50-degree field of view, 2228x1652:
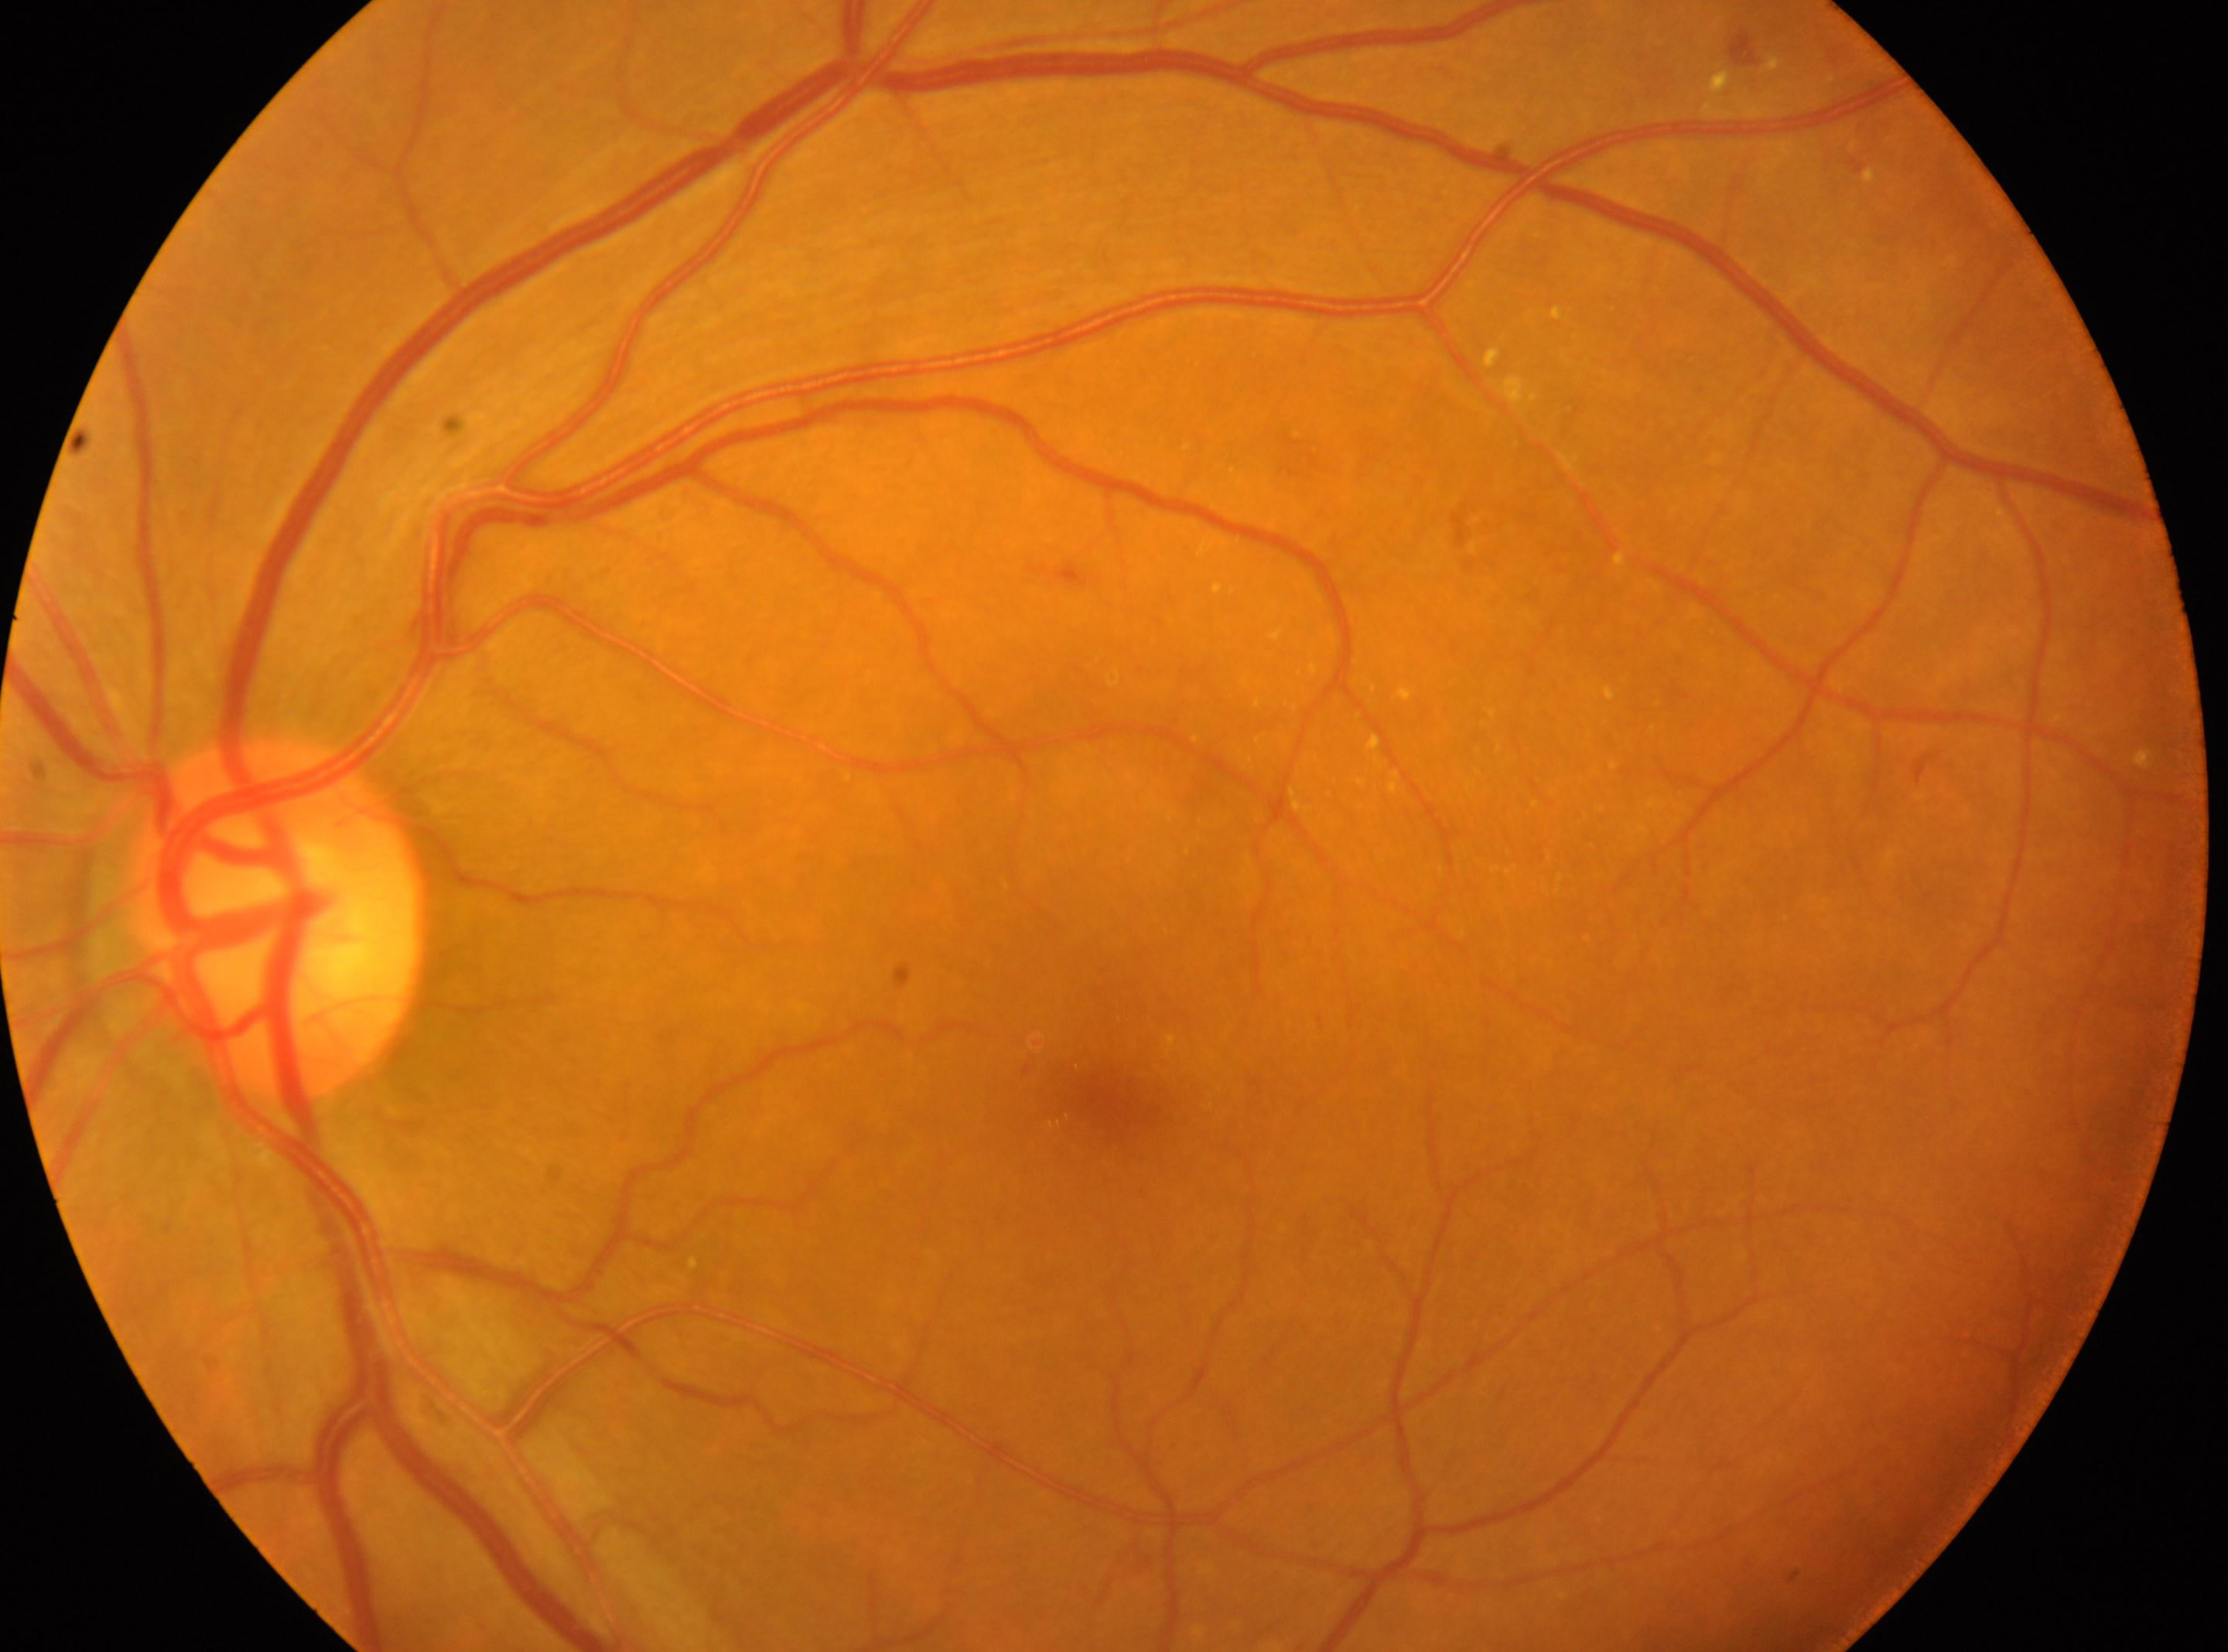

{"eye": "left", "dr_grade": "2", "optic_disc": "273, 919", "fovea": "1105, 1095"}